Davis DR grading
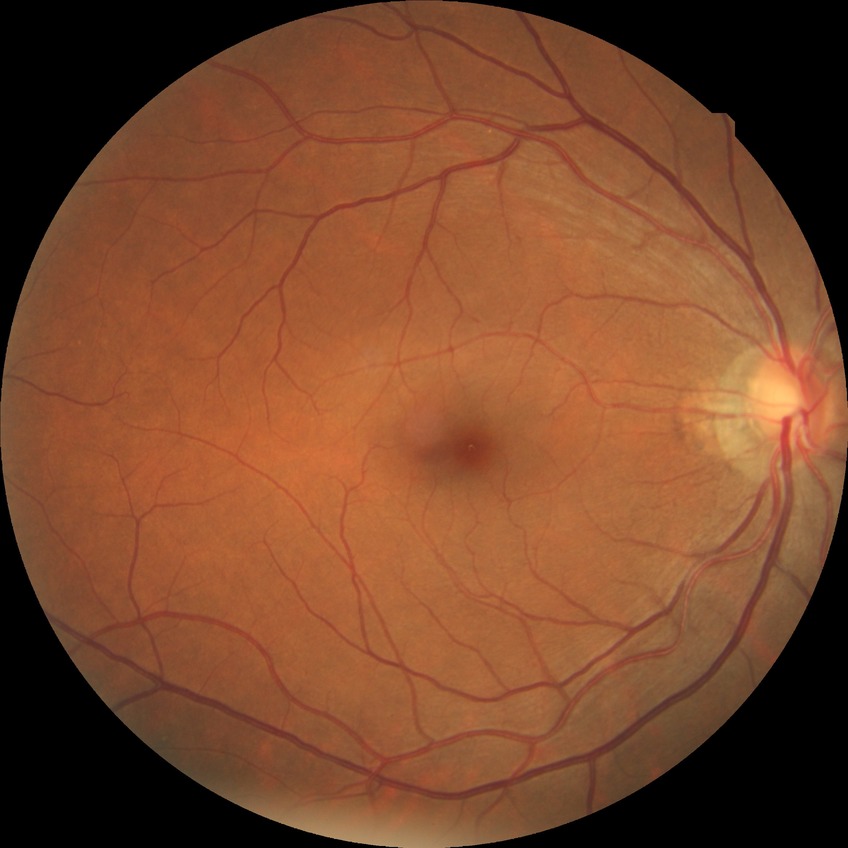

Davis grade: NDR.